Graded on the modified Davis scale.
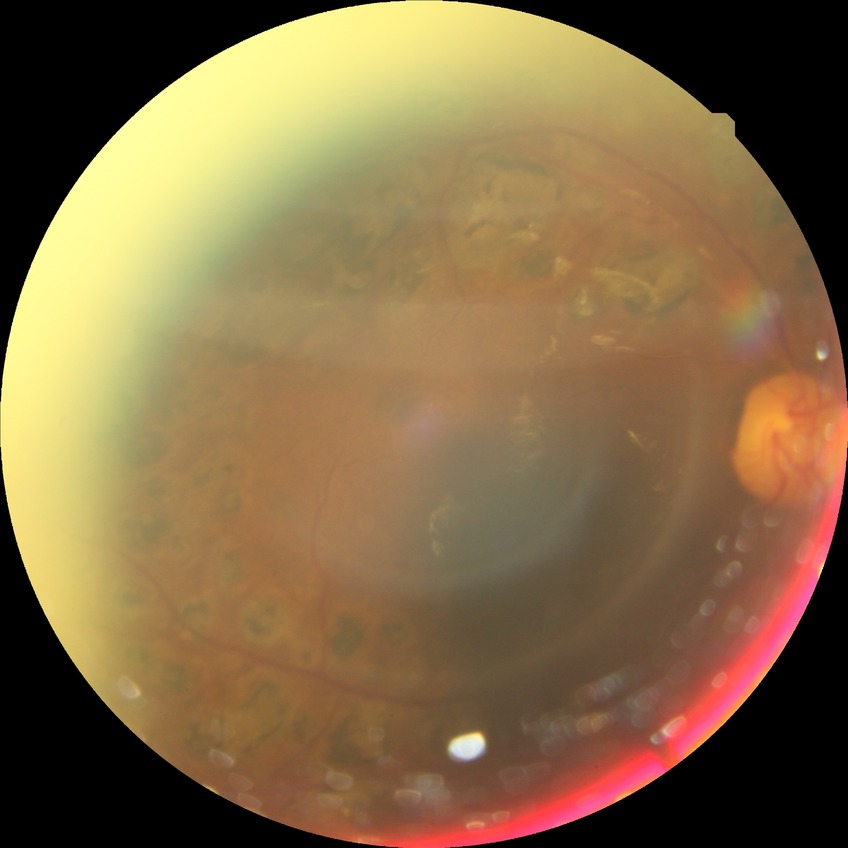
Diabetic retinopathy (DR): PDR (proliferative diabetic retinopathy).